Cropped to the optic nerve head:
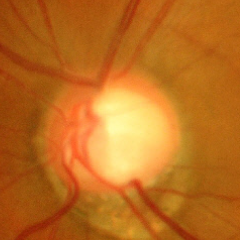
This fundus photograph shows advanced-stage glaucoma.